RetCam wide-field infant fundus image — 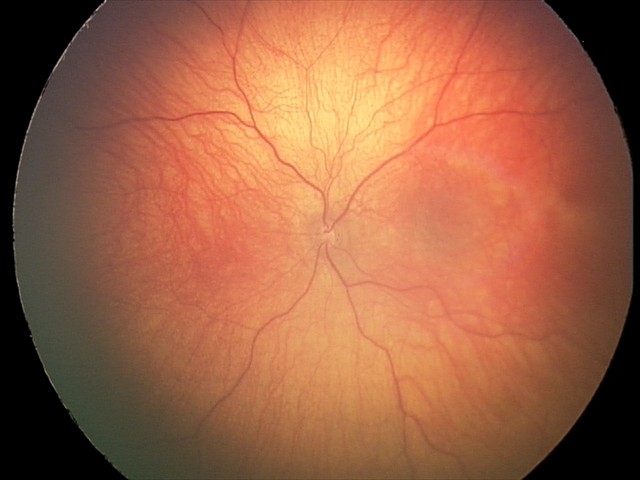 Screening examination consistent with optic nerve hypoplasia.